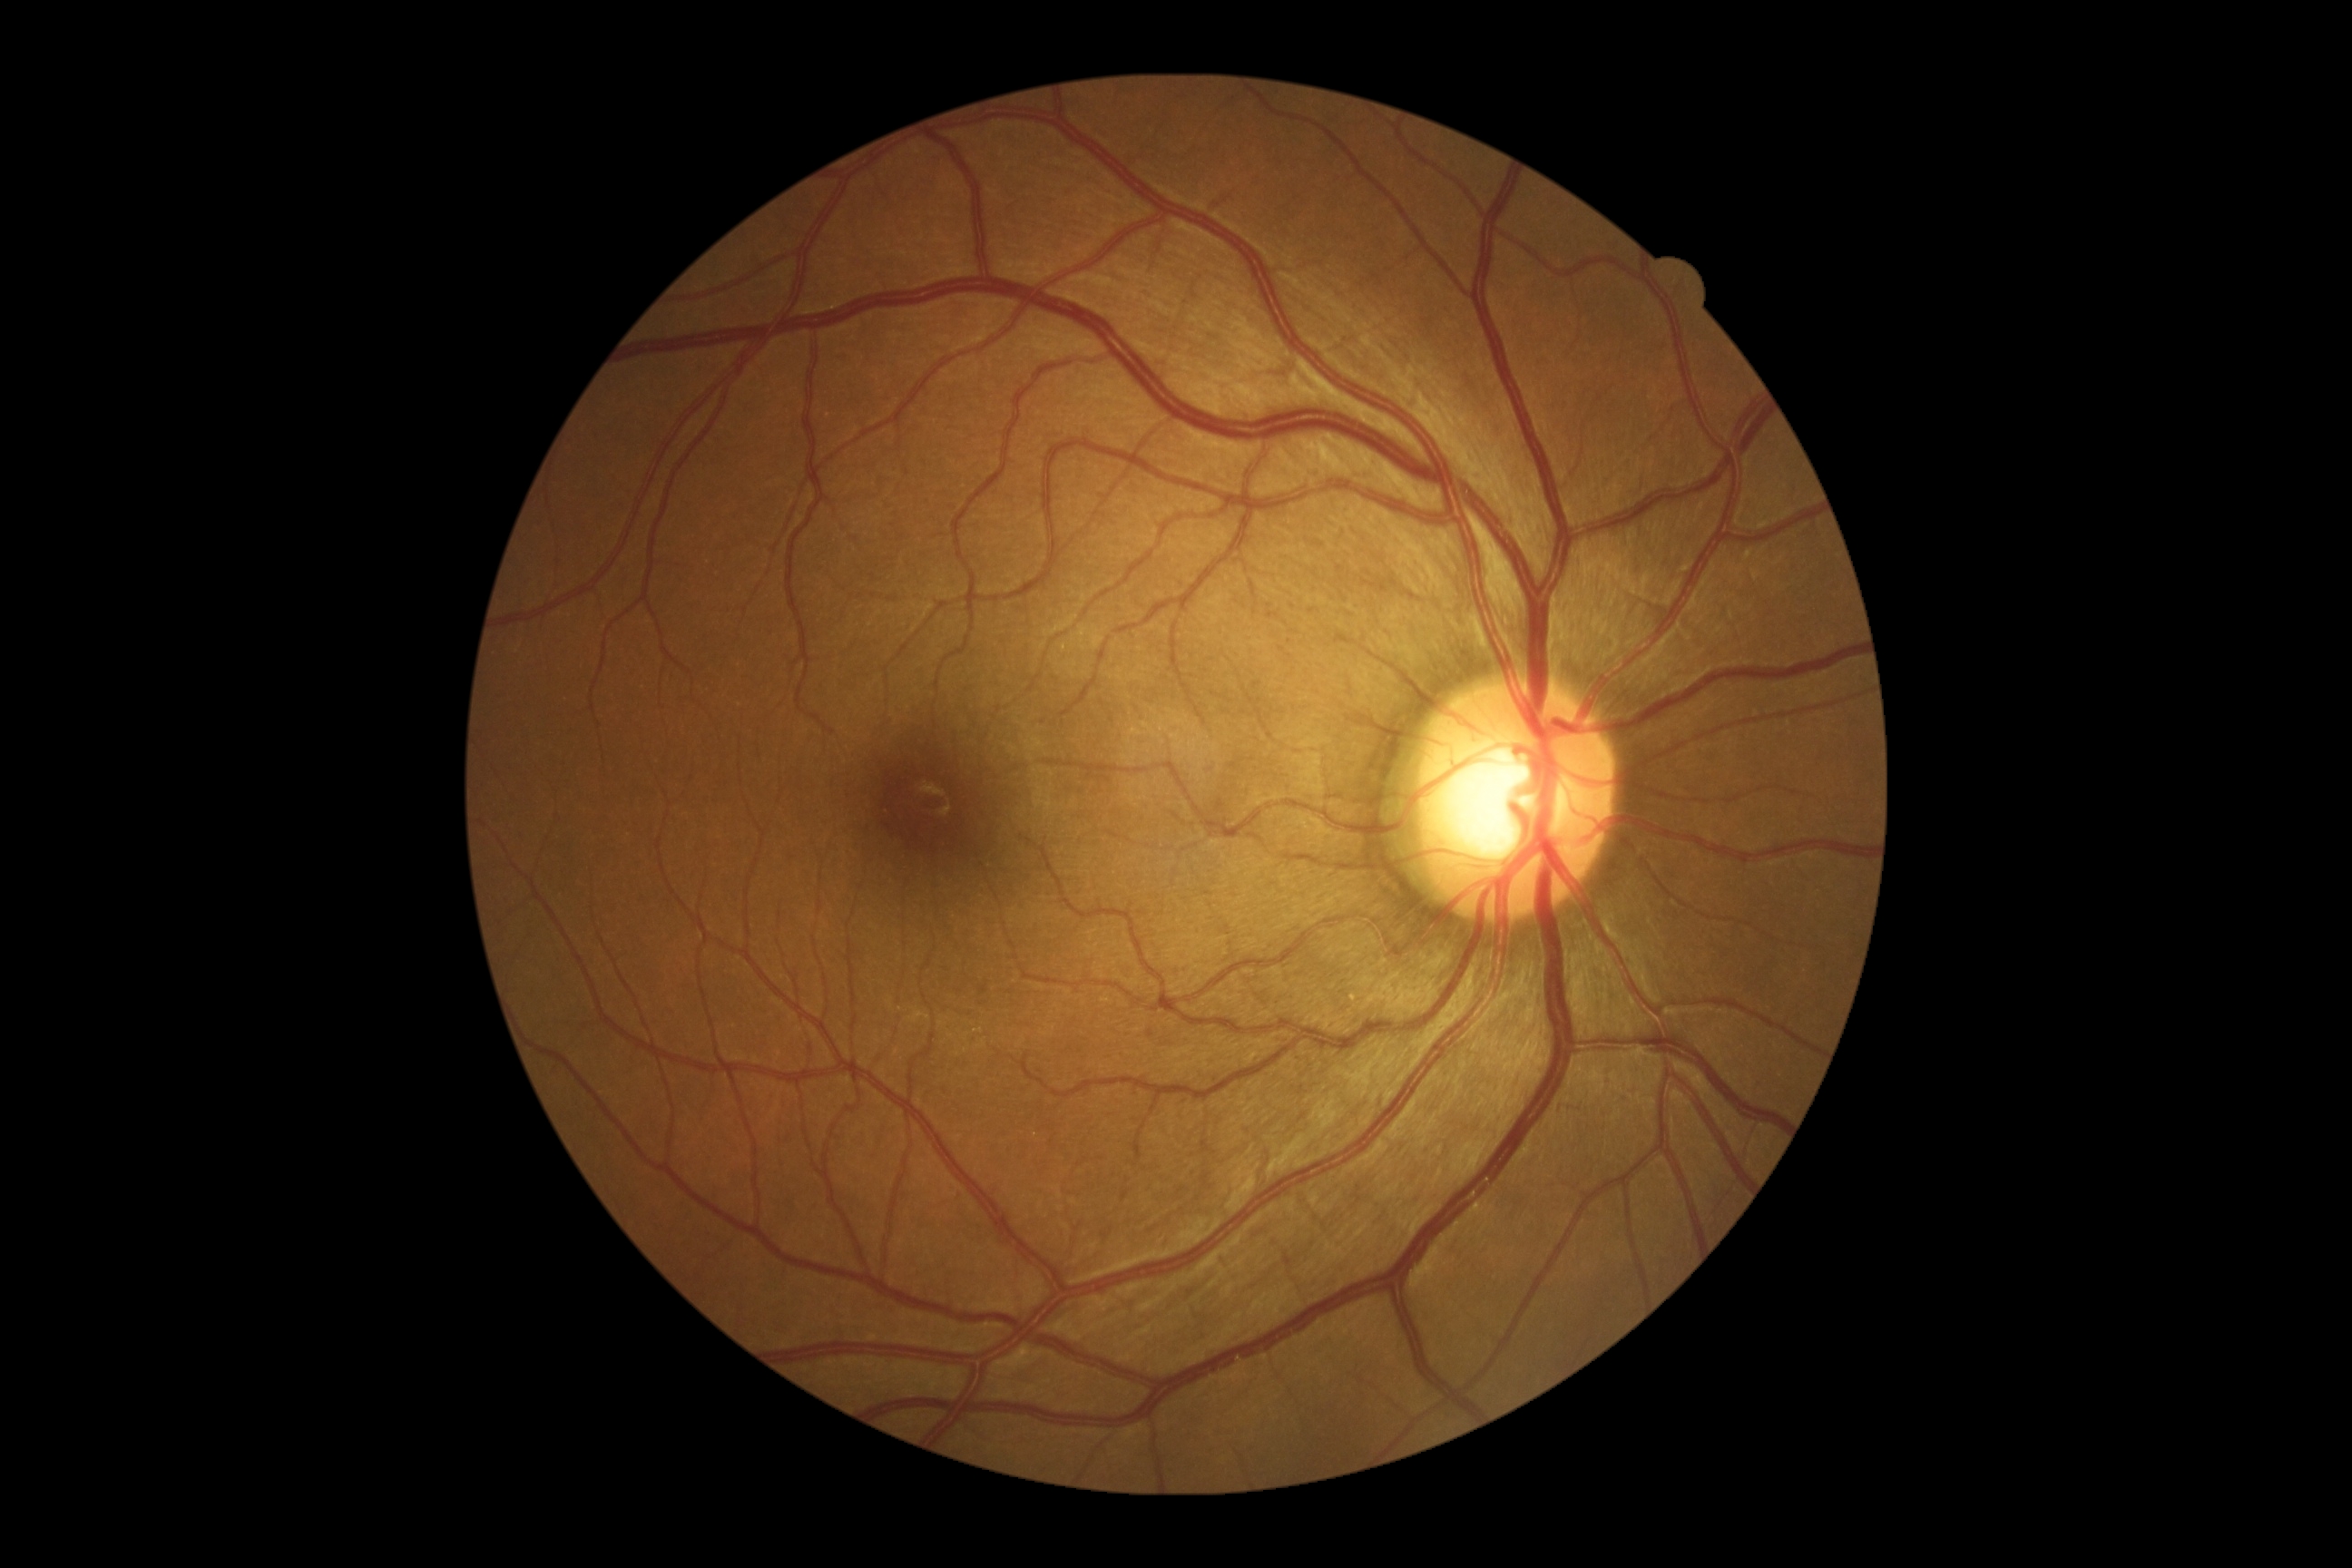 DR impression = no signs of DR; retinopathy = grade 0 — no visible signs of diabetic retinopathy.